Acquired with a NIDEK AFC-230: 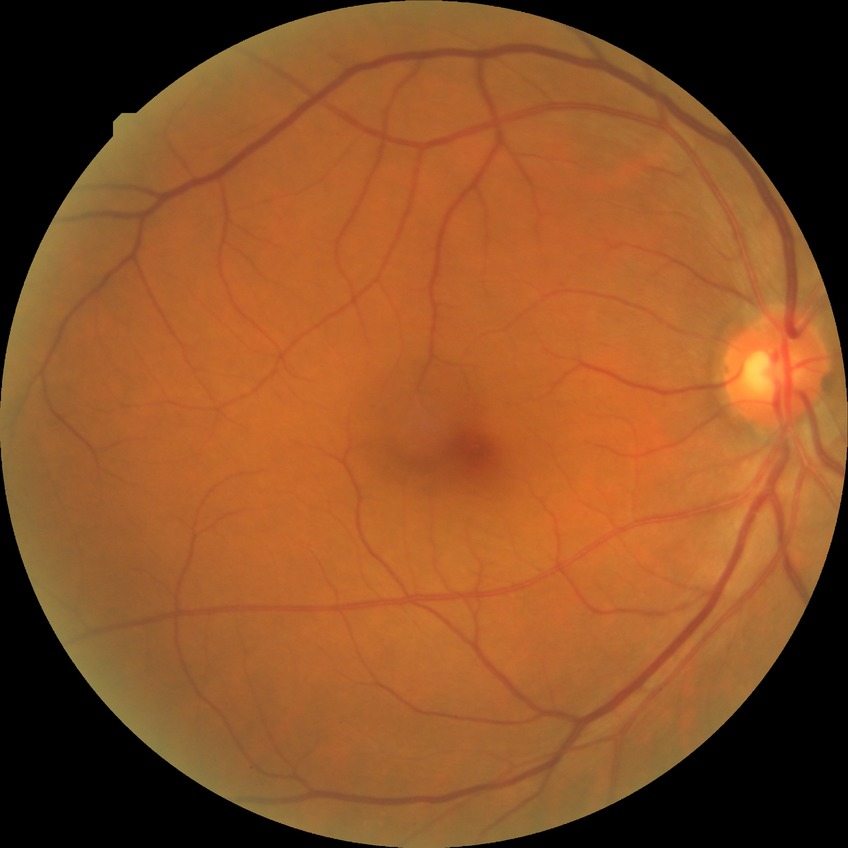 Diabetic retinopathy (DR) is NDR (no diabetic retinopathy).